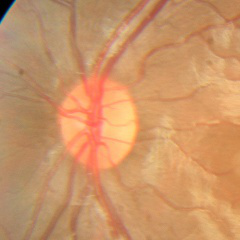 Q: What is the glaucoma diagnosis?
A: No glaucoma.